Retinal fundus photograph; axial length (AL): 22.8 mm; captured on a Topcon TRC-NW400 fundus camera; optic disc-centered — 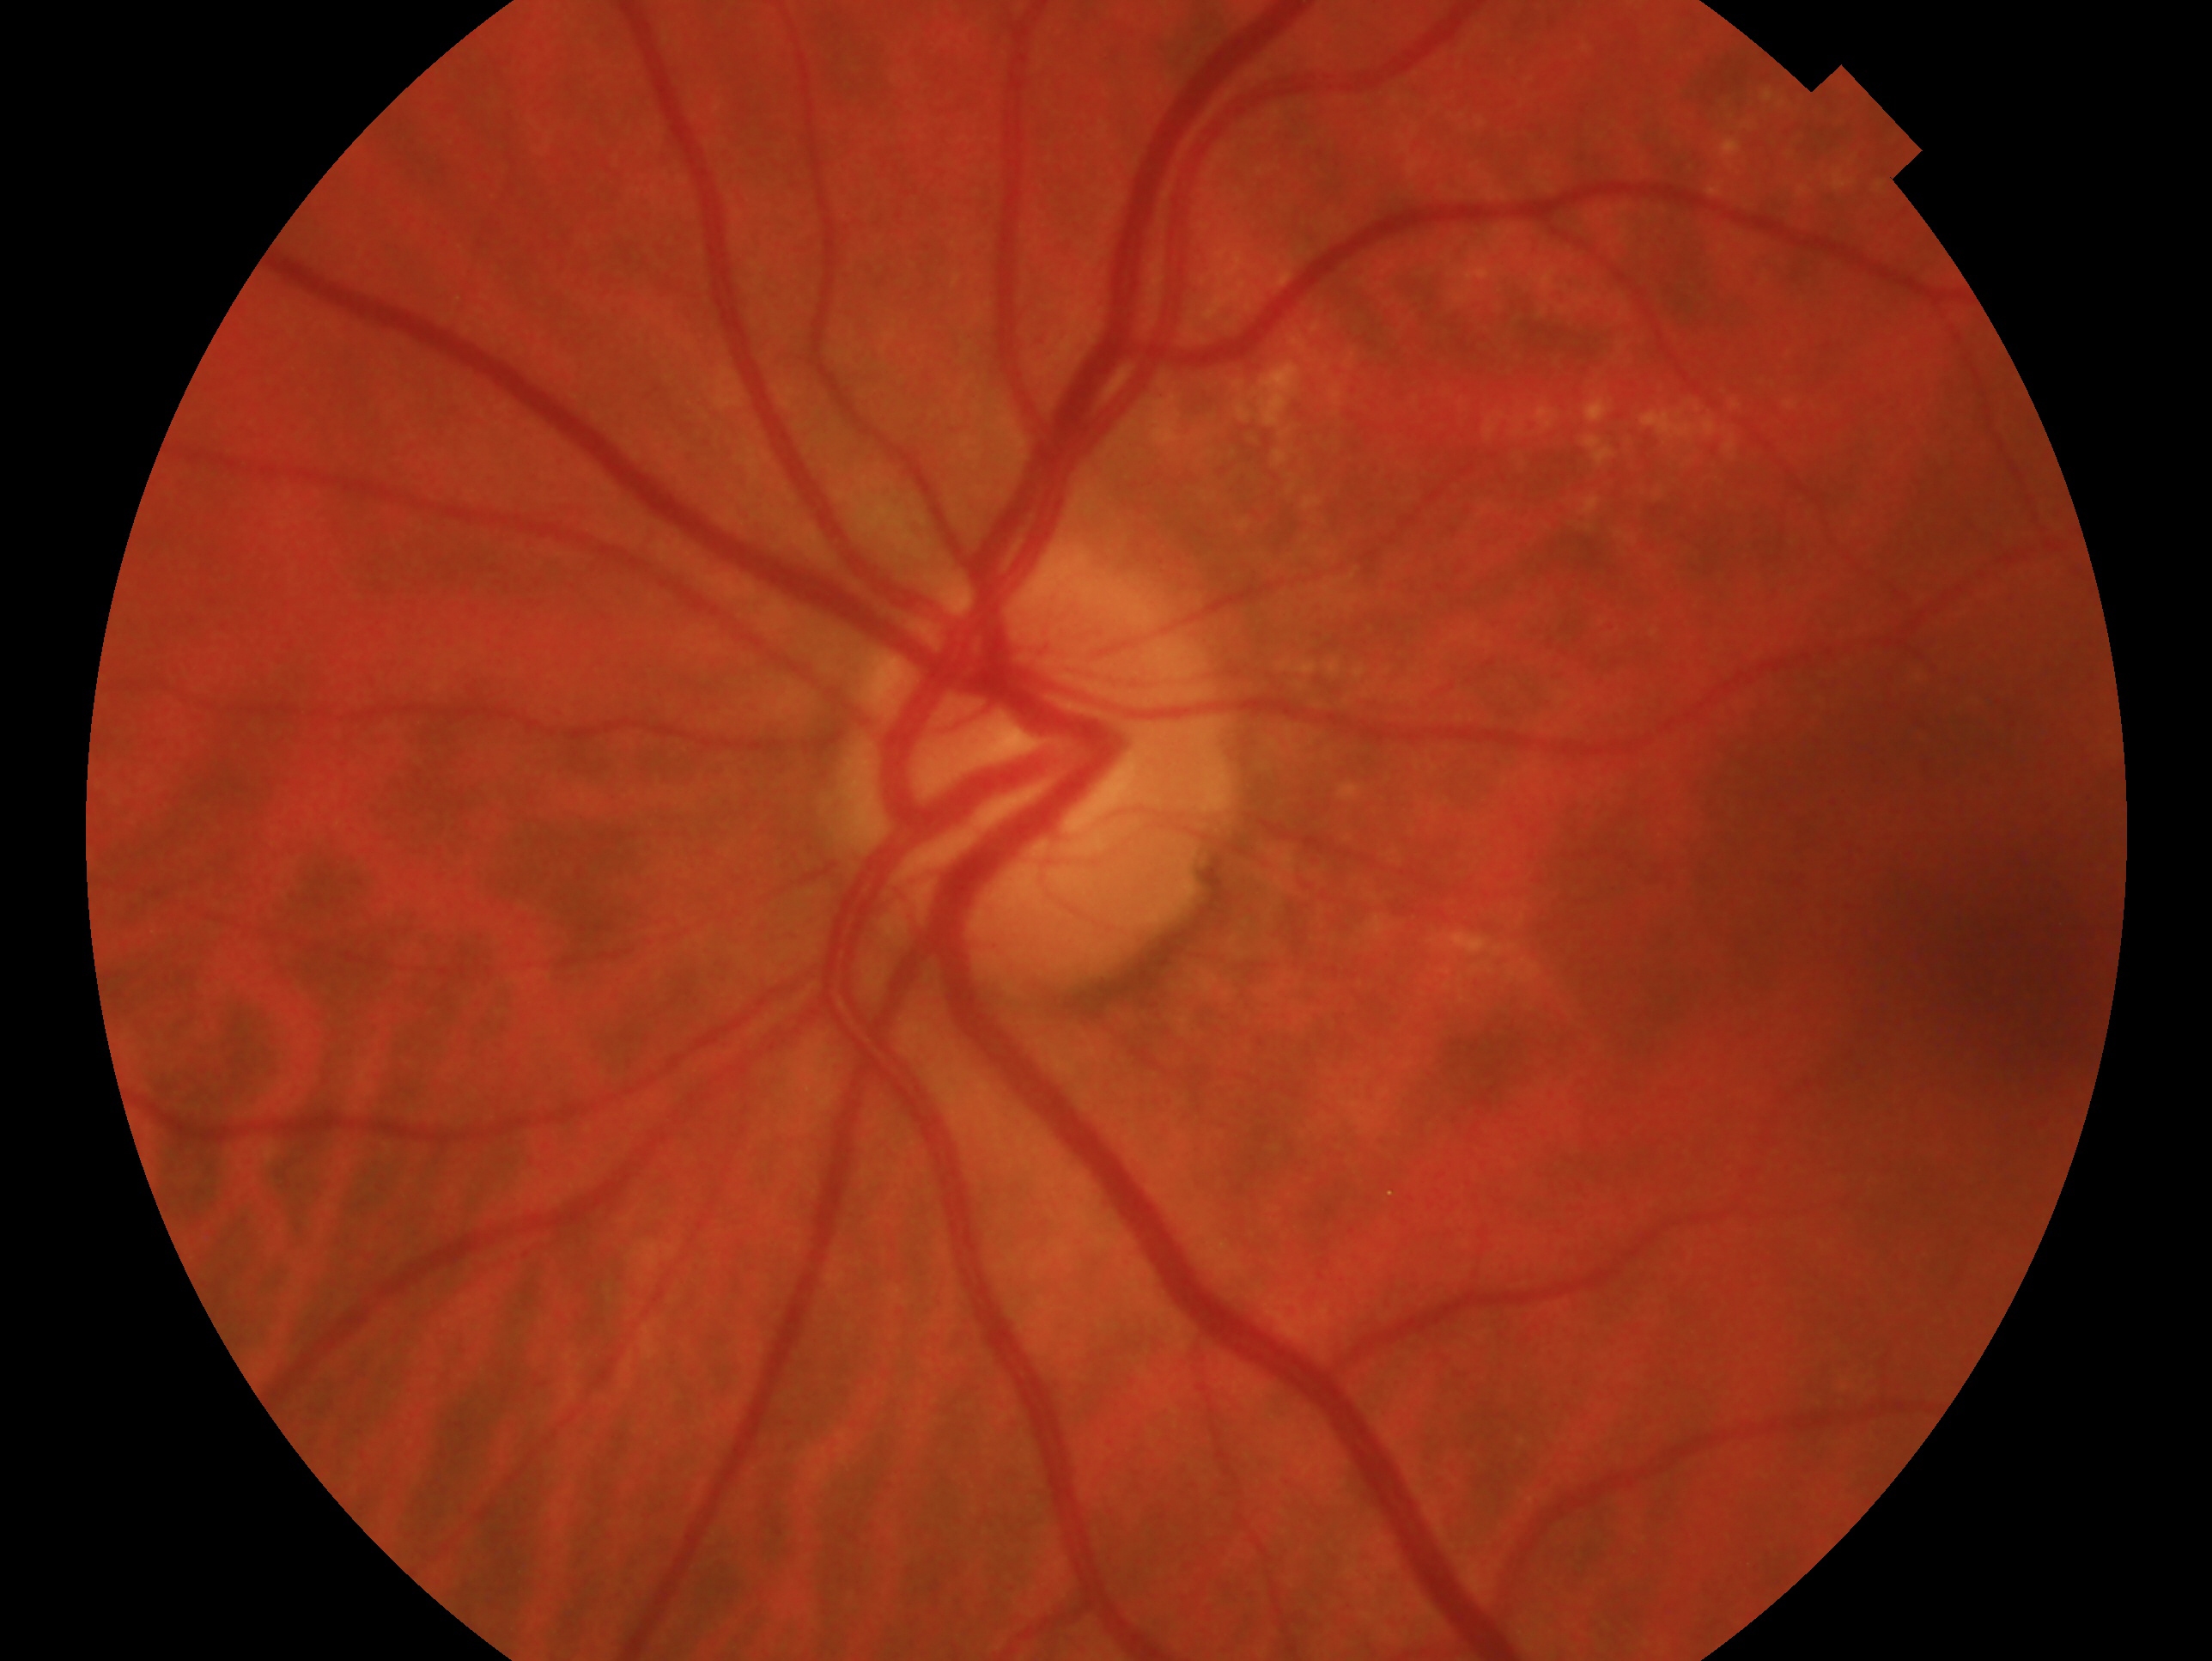

This is the OS. Diagnosis: no signs of glaucoma — no clinical evidence of glaucoma in this eye.